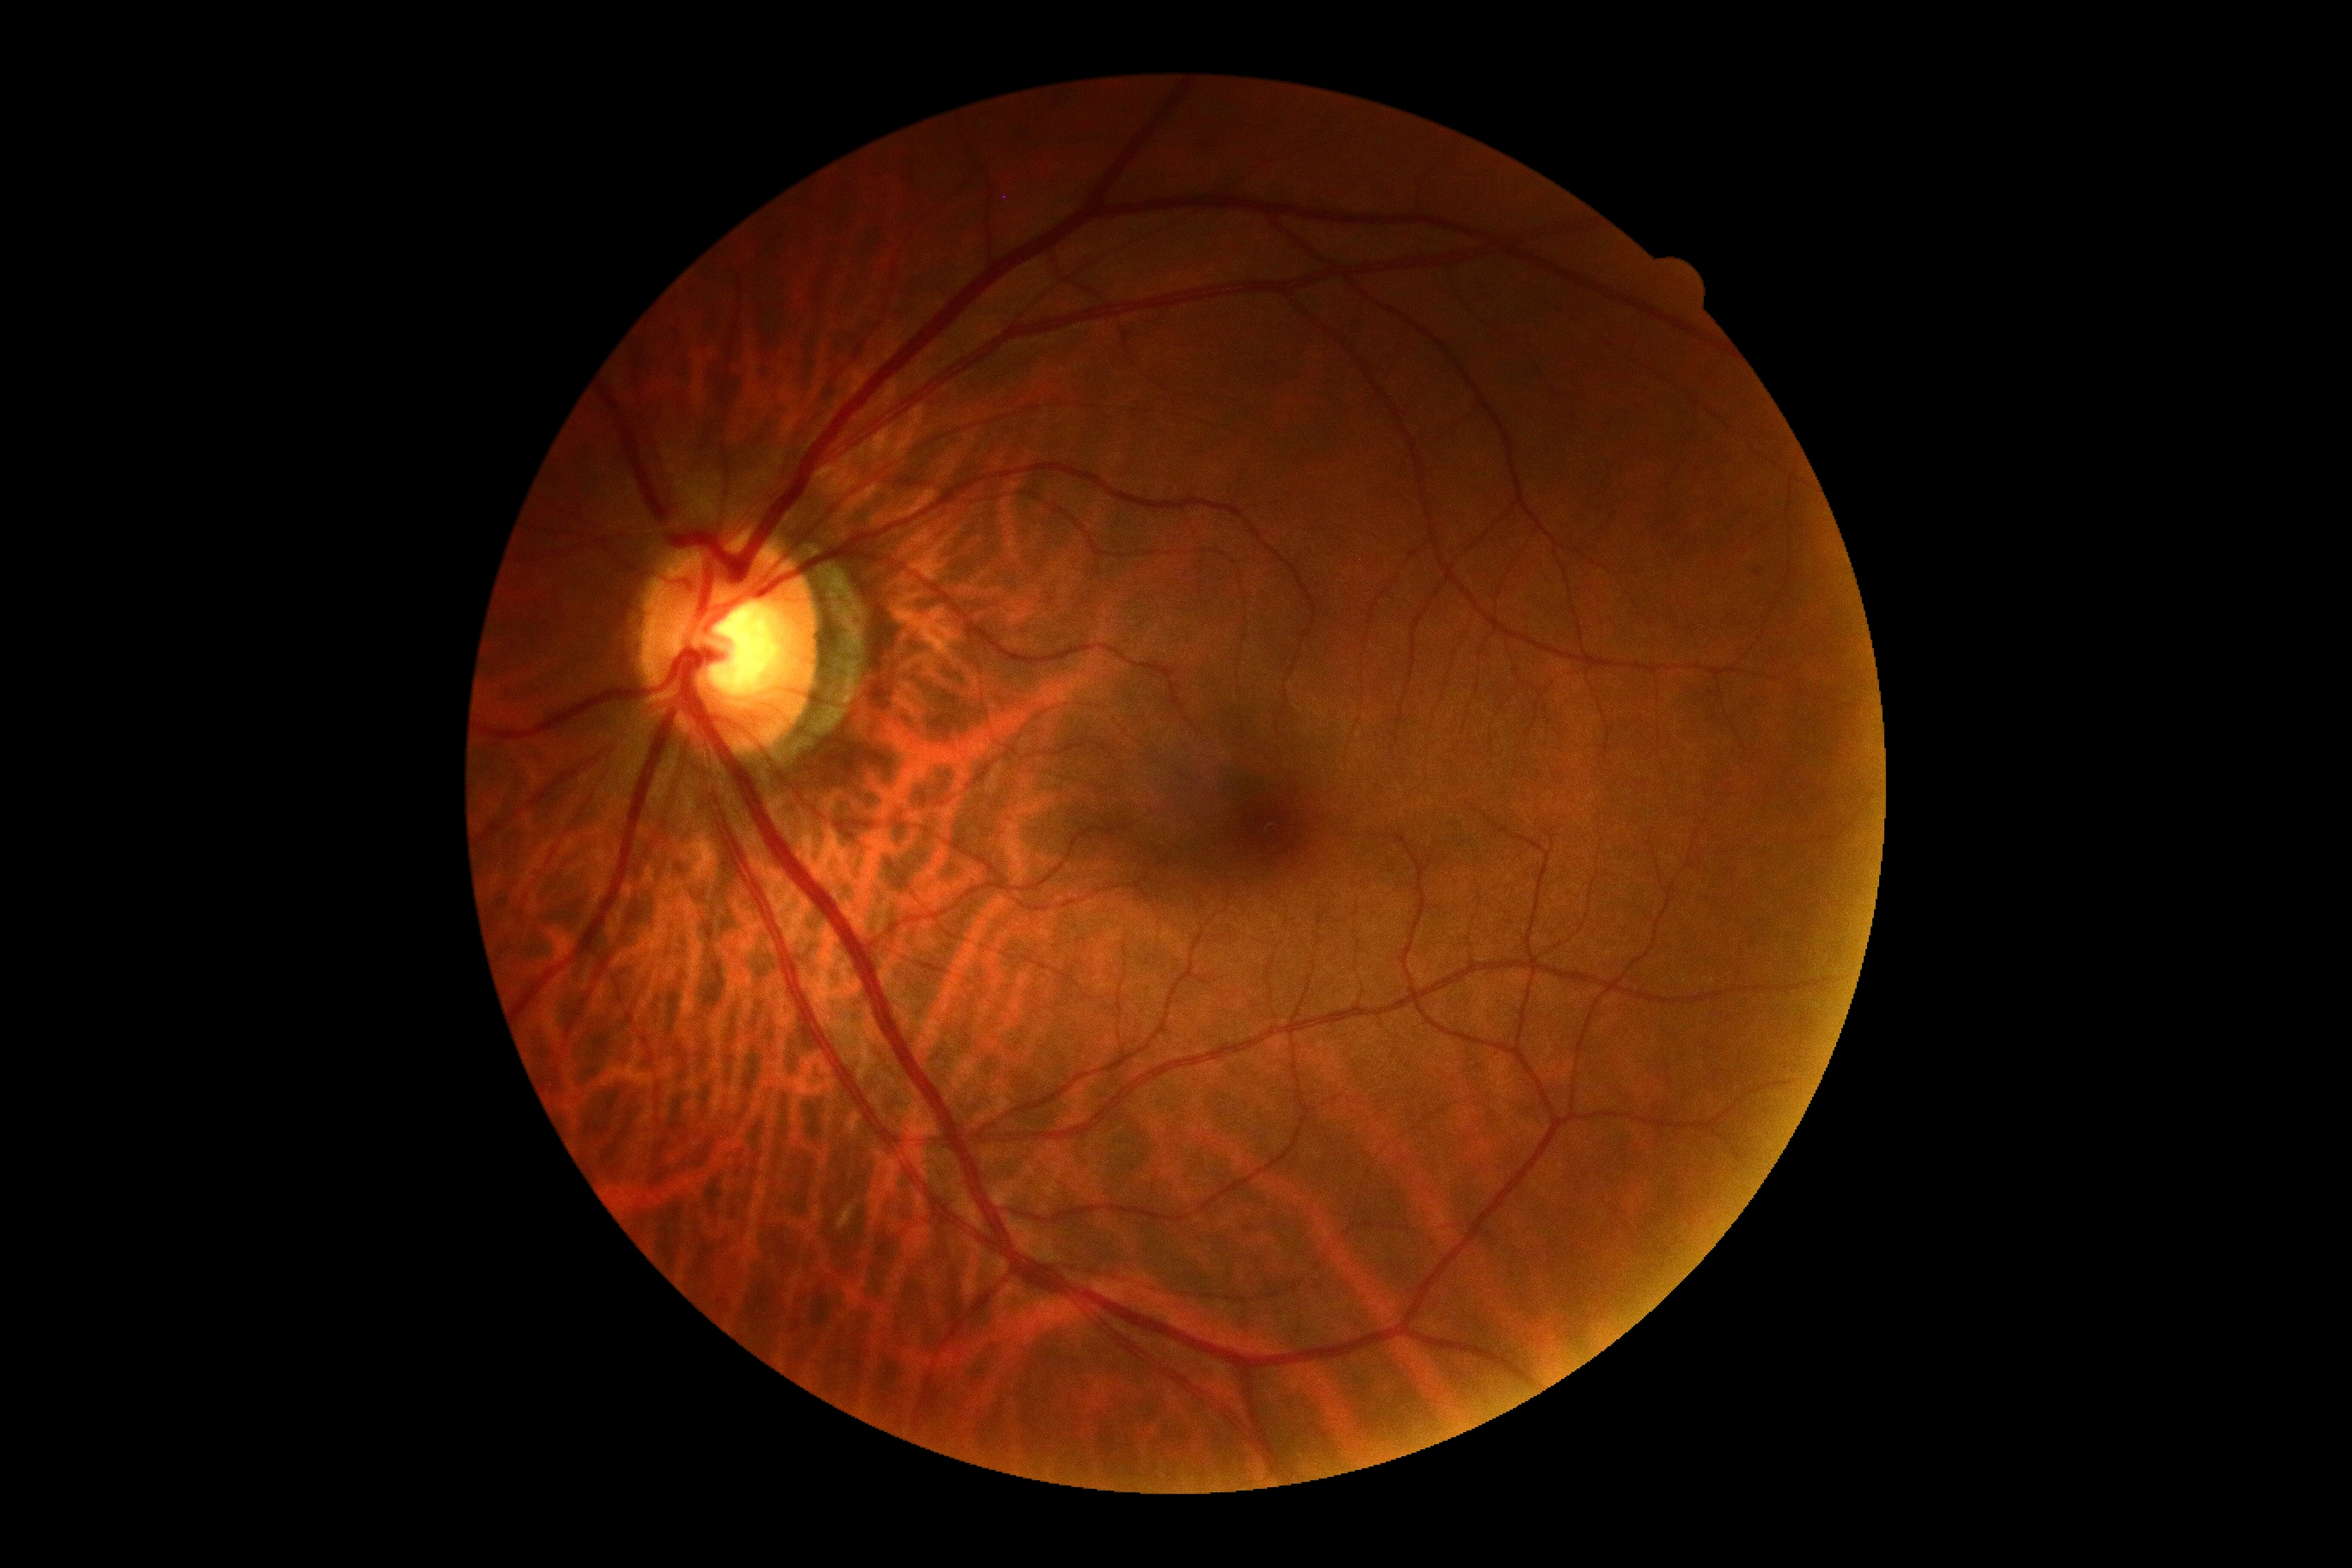 Diabetic retinopathy severity: 0/4.